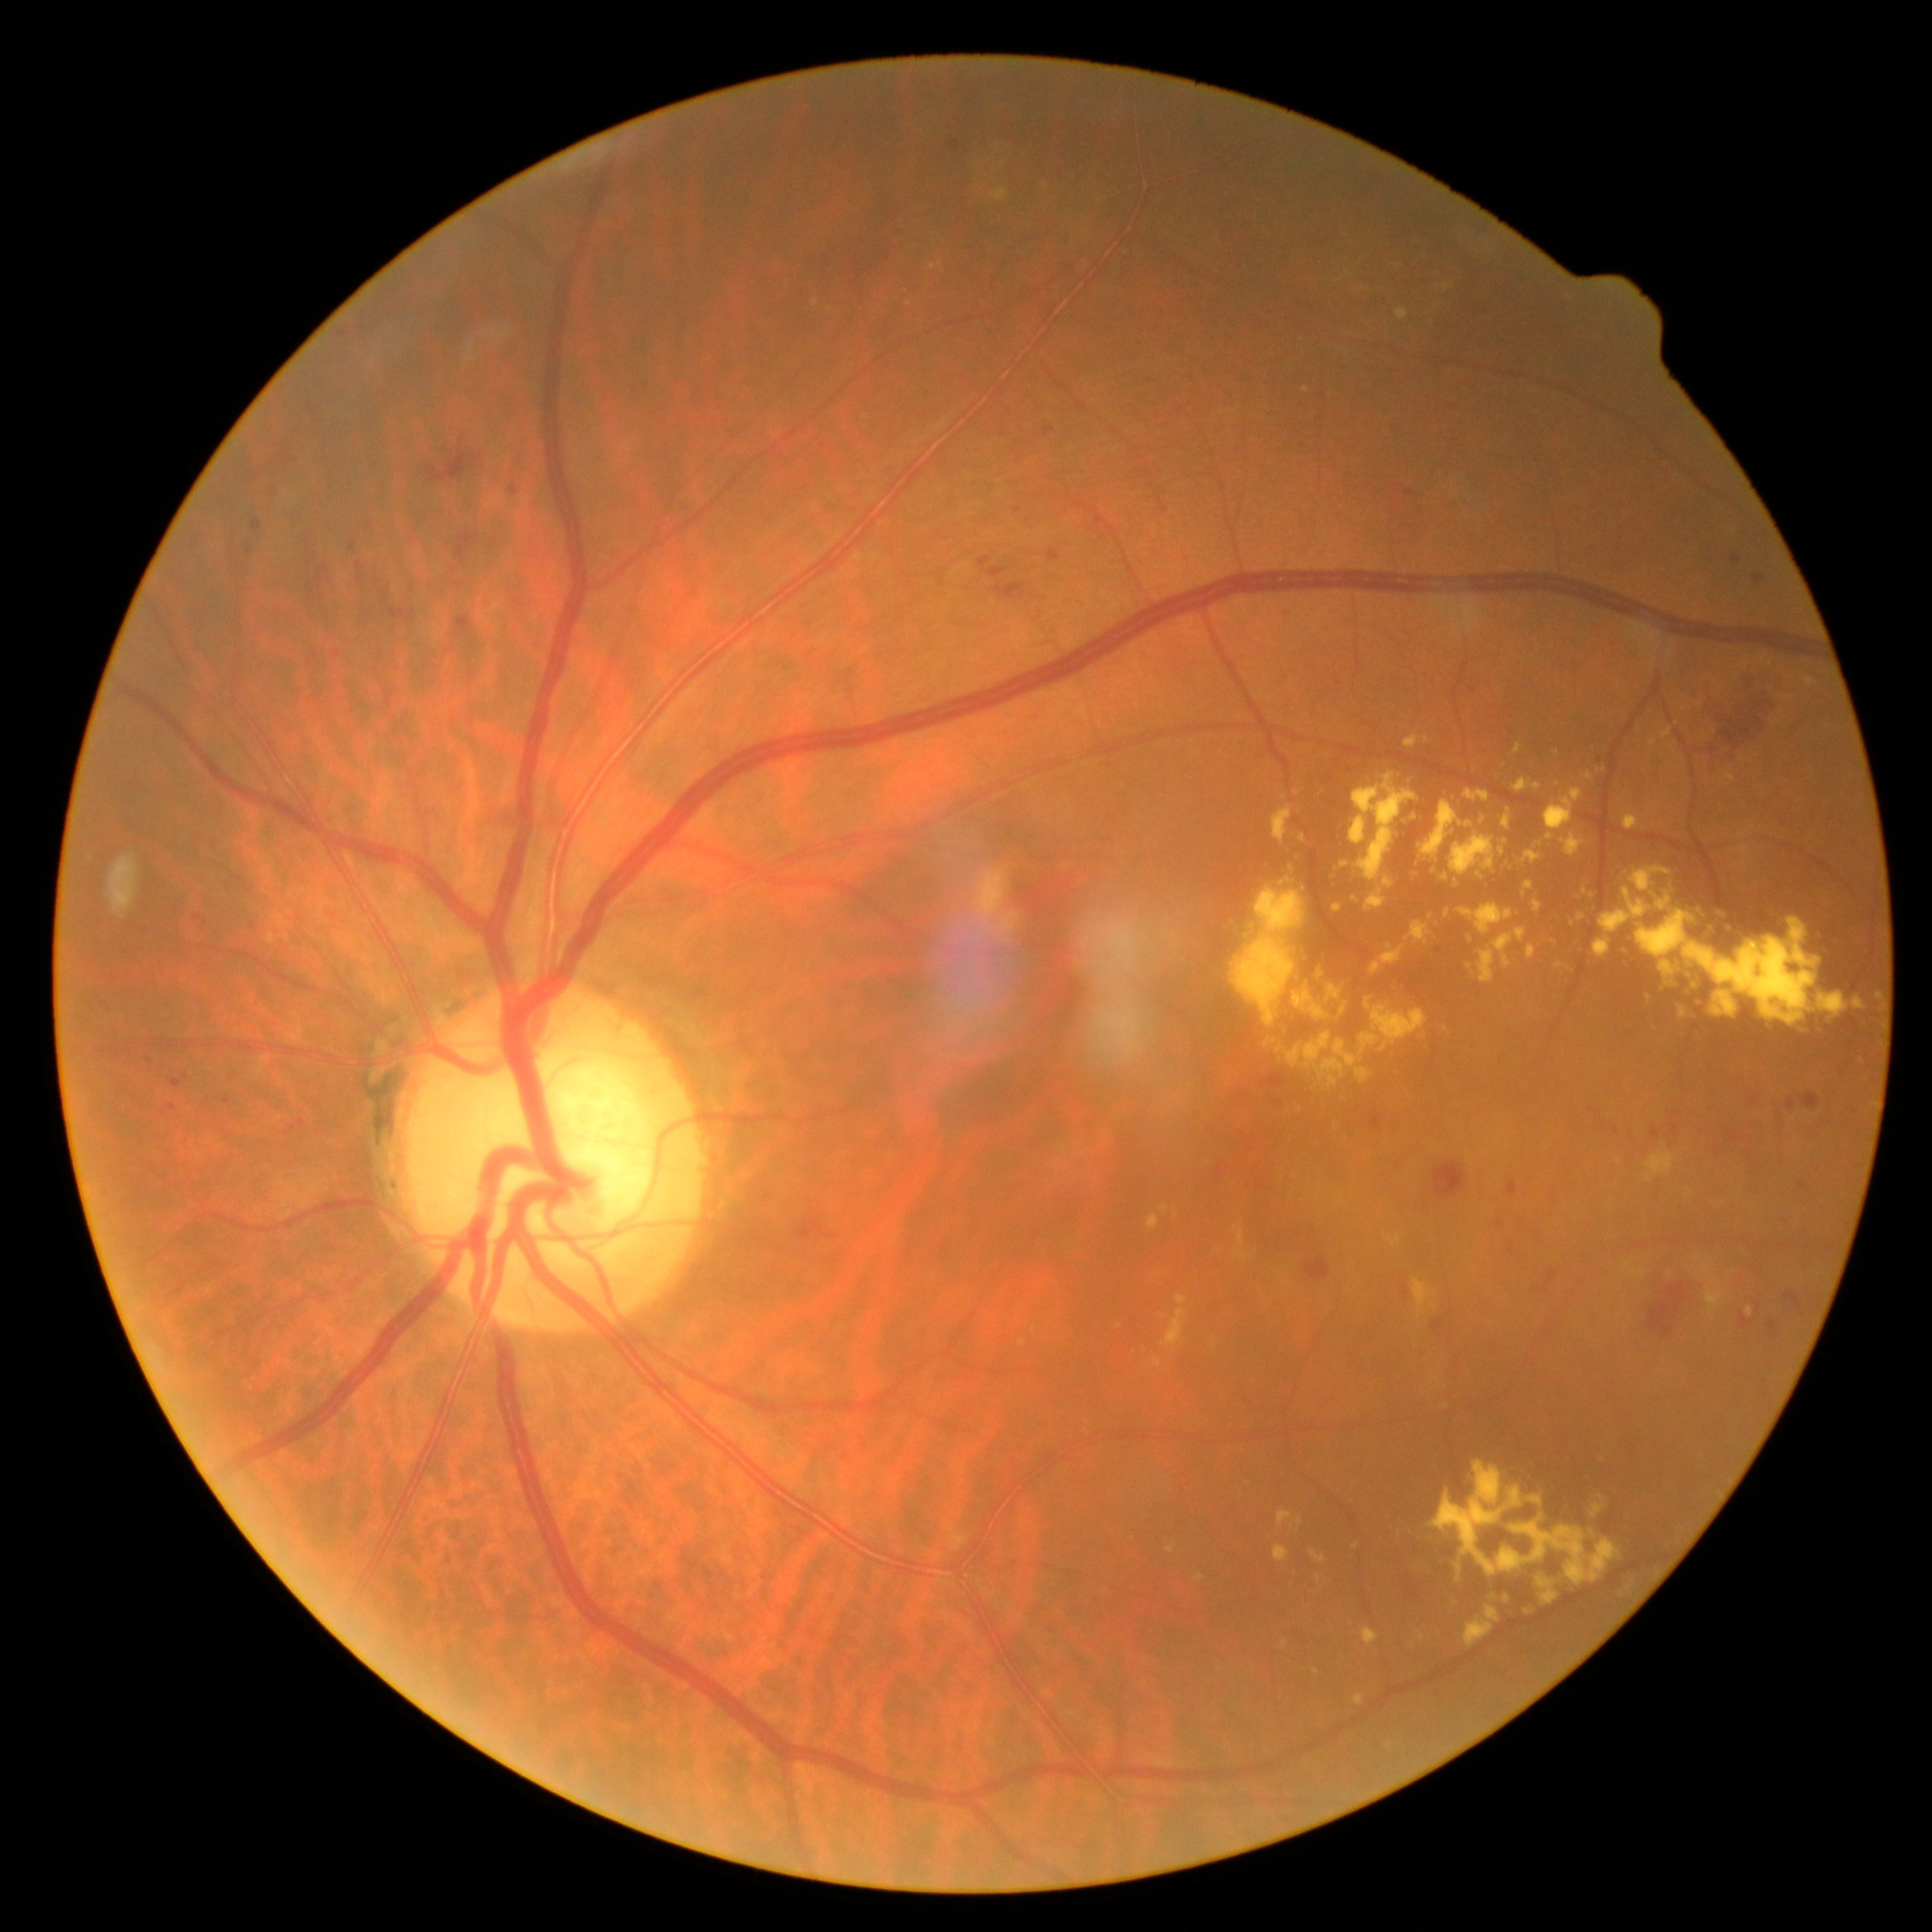
Diabetic retinopathy severity: grade 2.
Hemorrhages are present, including at (x1=1306, y1=709, x2=1321, y2=725) | (x1=821, y1=589, x2=830, y2=598) | (x1=326, y1=904, x2=345, y2=923) | (x1=356, y1=563, x2=364, y2=585) | (x1=1433, y1=1161, x2=1465, y2=1200) | (x1=318, y1=574, x2=332, y2=583) | (x1=801, y1=185, x2=910, y2=306) | (x1=299, y1=1117, x2=306, y2=1126) | (x1=1624, y1=1129, x2=1640, y2=1148) | (x1=194, y1=914, x2=203, y2=922) | (x1=1048, y1=550, x2=1060, y2=562) | (x1=171, y1=1079, x2=182, y2=1088).
Hemorrhages (small, approximate centers) near [1500,1224] | [1600,760] | [1019,509] | [1280,1103] | [412,588].
Hard exudates are present, including at (x1=1291, y1=1517, x2=1303, y2=1531) | (x1=931, y1=263, x2=943, y2=270) | (x1=951, y1=1531, x2=967, y2=1551) | (x1=813, y1=299, x2=819, y2=308) | (x1=1173, y1=1209, x2=1177, y2=1218) | (x1=1149, y1=1215, x2=1159, y2=1229) | (x1=1356, y1=1693, x2=1365, y2=1704) | (x1=1389, y1=1447, x2=1640, y2=1652) | (x1=1645, y1=1149, x2=1677, y2=1182) | (x1=1746, y1=1306, x2=1754, y2=1315) | (x1=1274, y1=1546, x2=1289, y2=1562).
Hard exudates (small, approximate centers) near [1022,1344] | [1356,1546] | [1348,273] | [1793,1119] | [1165,1316] | [1685,709].